848x848px.
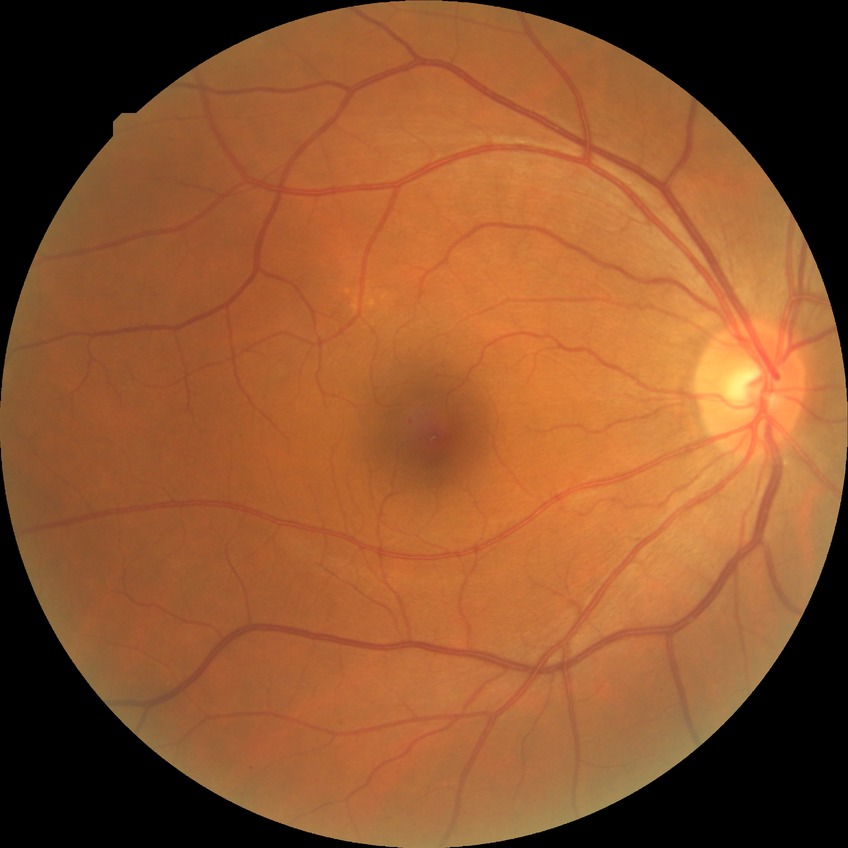
Diabetic retinopathy (DR): NDR (no diabetic retinopathy).